Fundus photo · captured after pupil dilation
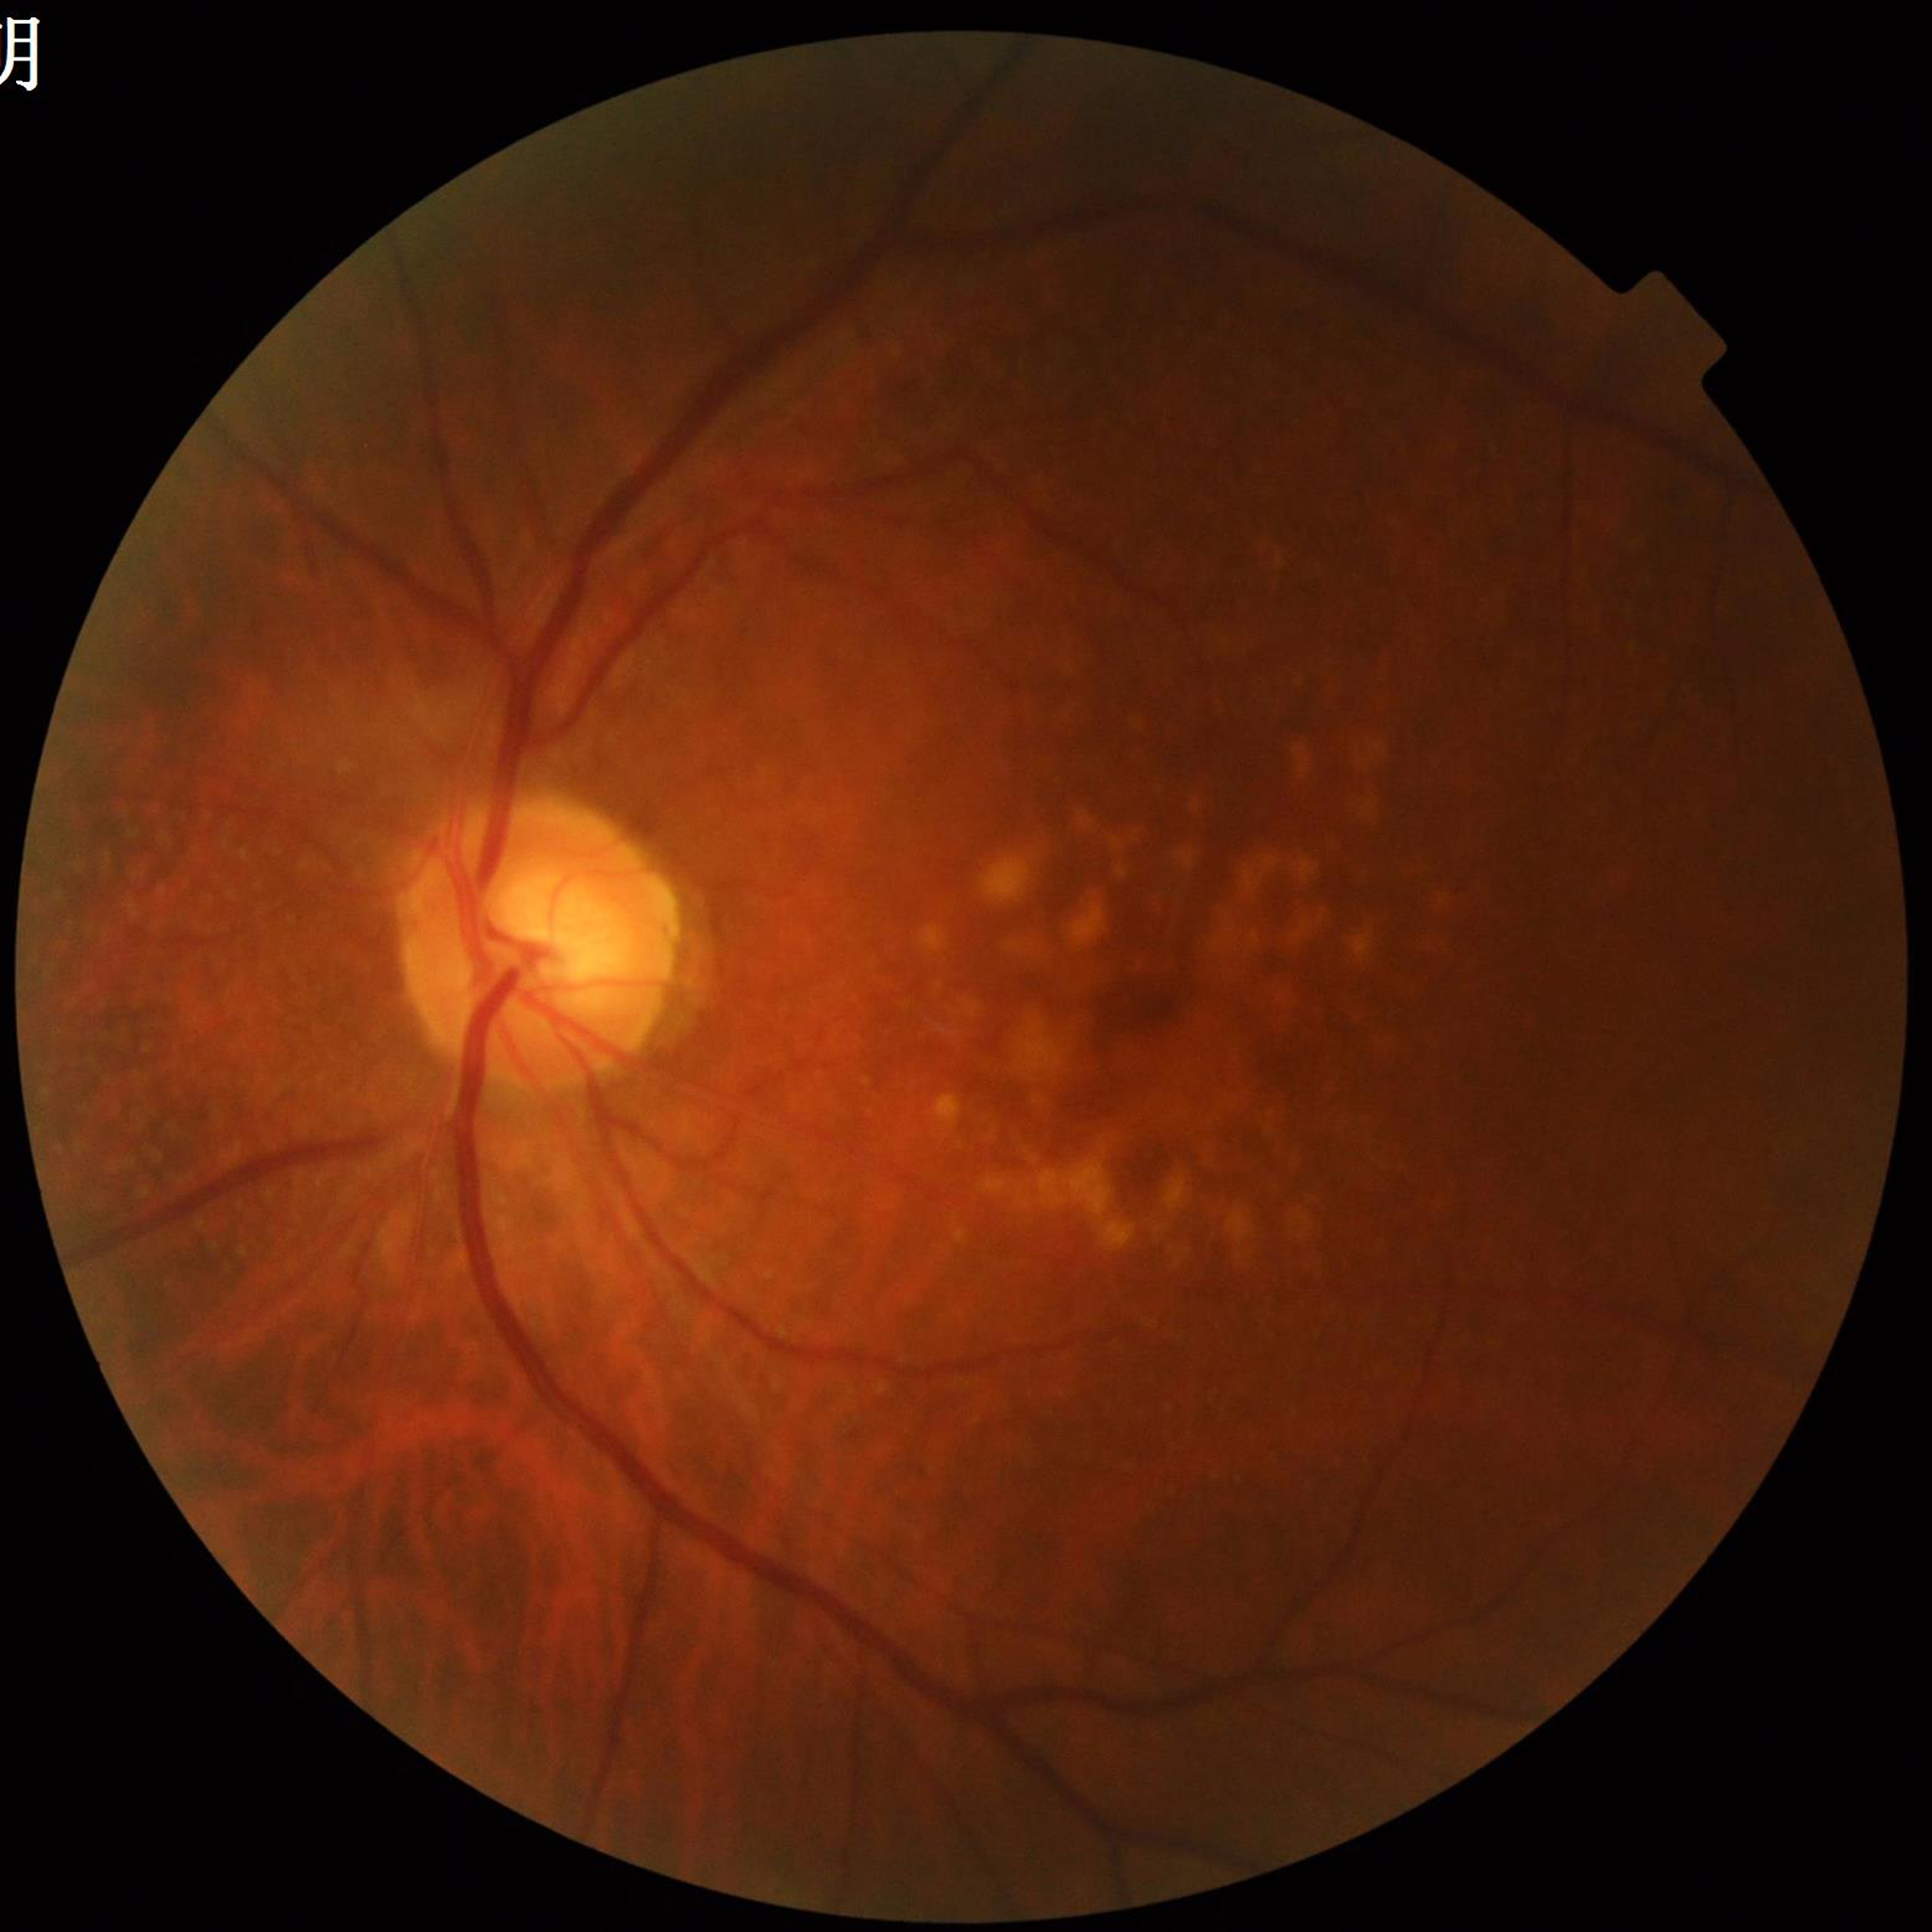 Quality: satisfactory; Condition: age-related macular degeneration.